Acquired on the Clarity RetCam 3; wide-field fundus image from infant ROP screening
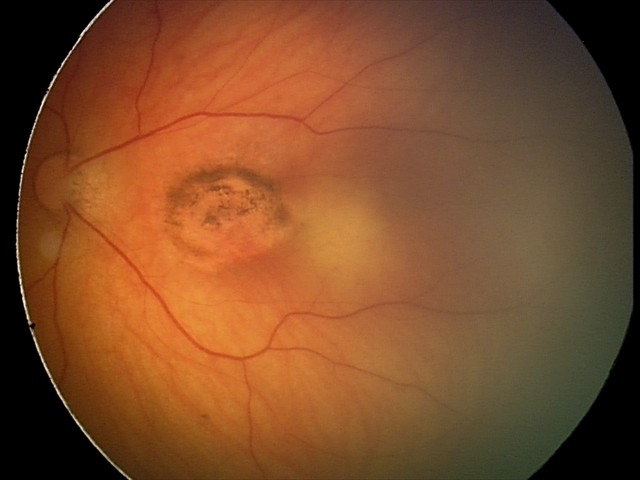
Diagnosis = toxoplasmosis chorioretinitis